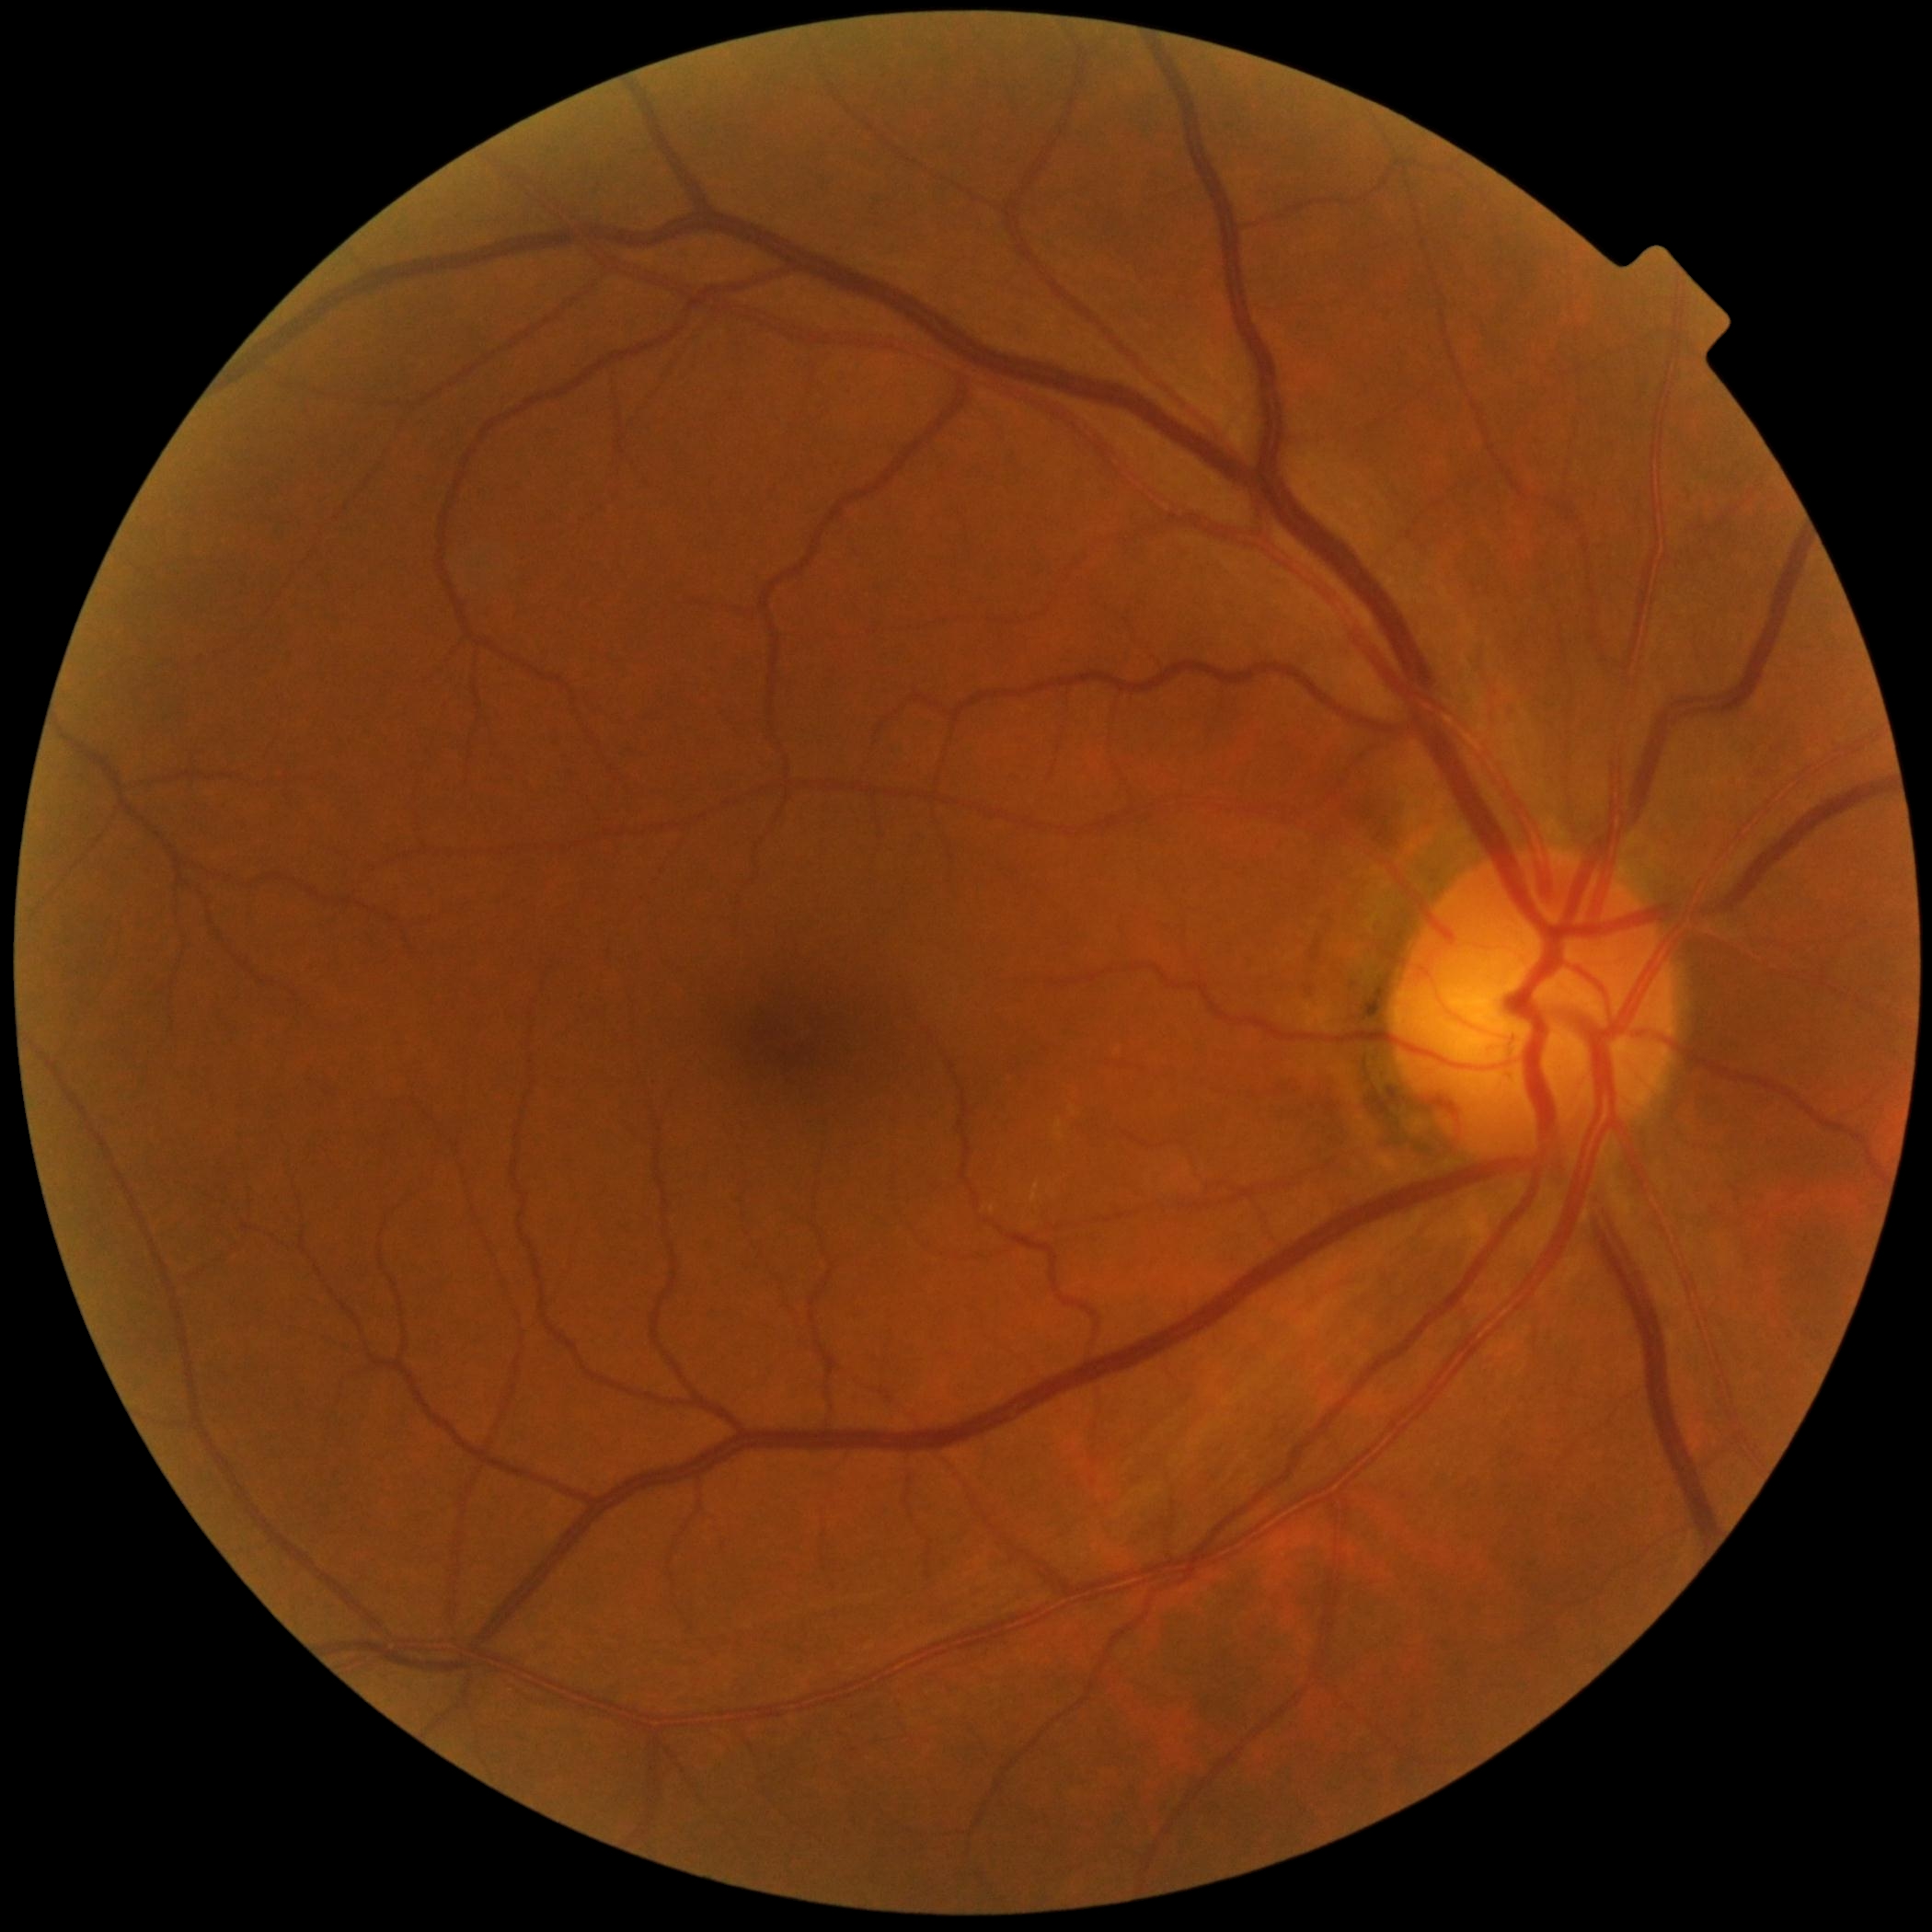 DR impression@no DR findings, diabetic retinopathy (DR)@no apparent diabetic retinopathy (grade 0).